Color fundus photograph, acquired with a NIDEK AFC-230: 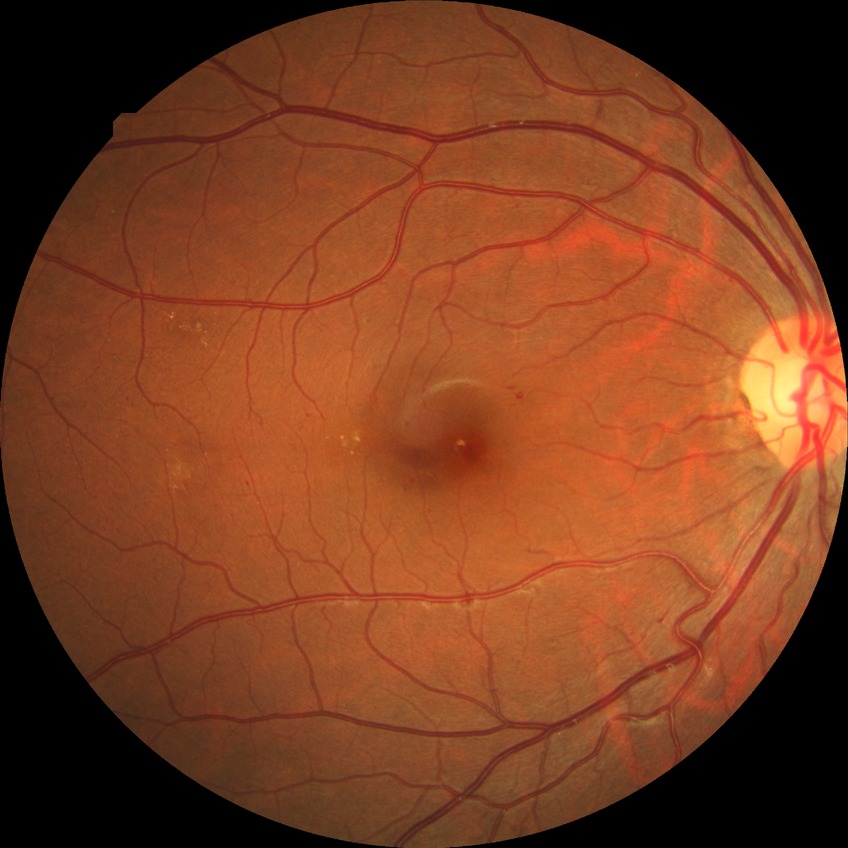 Findings:
- diabetic retinopathy stage: simple diabetic retinopathy